Phoenix ICON wide-field infant fundus image · 100° field of view (Phoenix ICON)
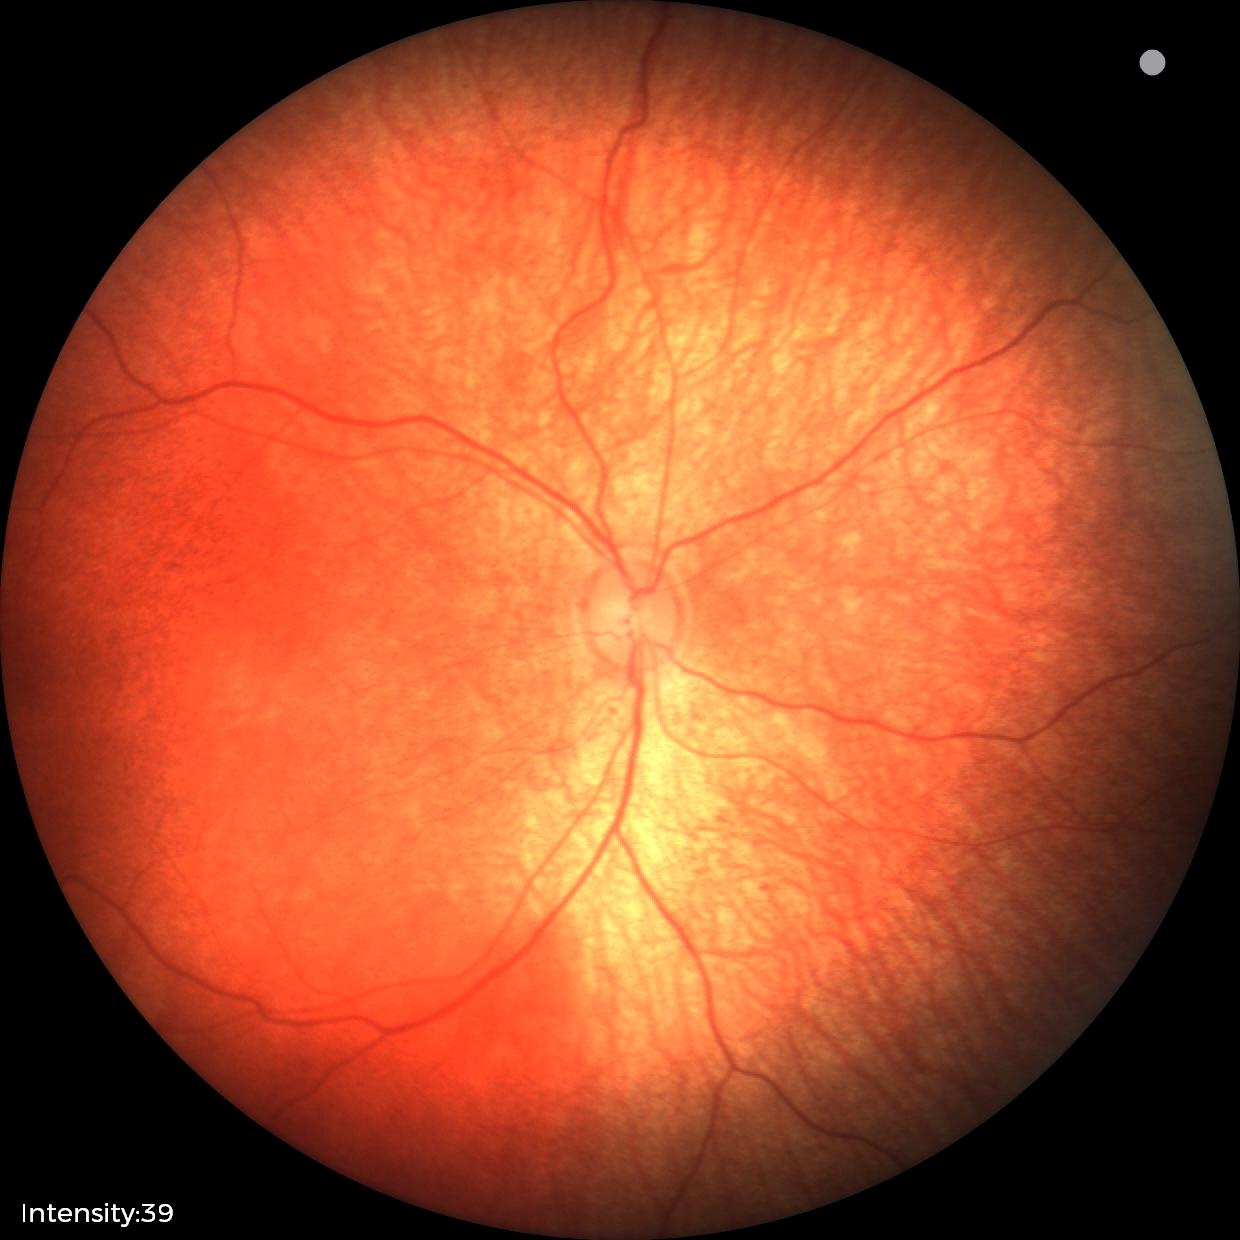 Impression: no abnormalities.